Acquired with a Remidio Fundus on Phone (FOP) camera. 1659 by 2212 pixels: 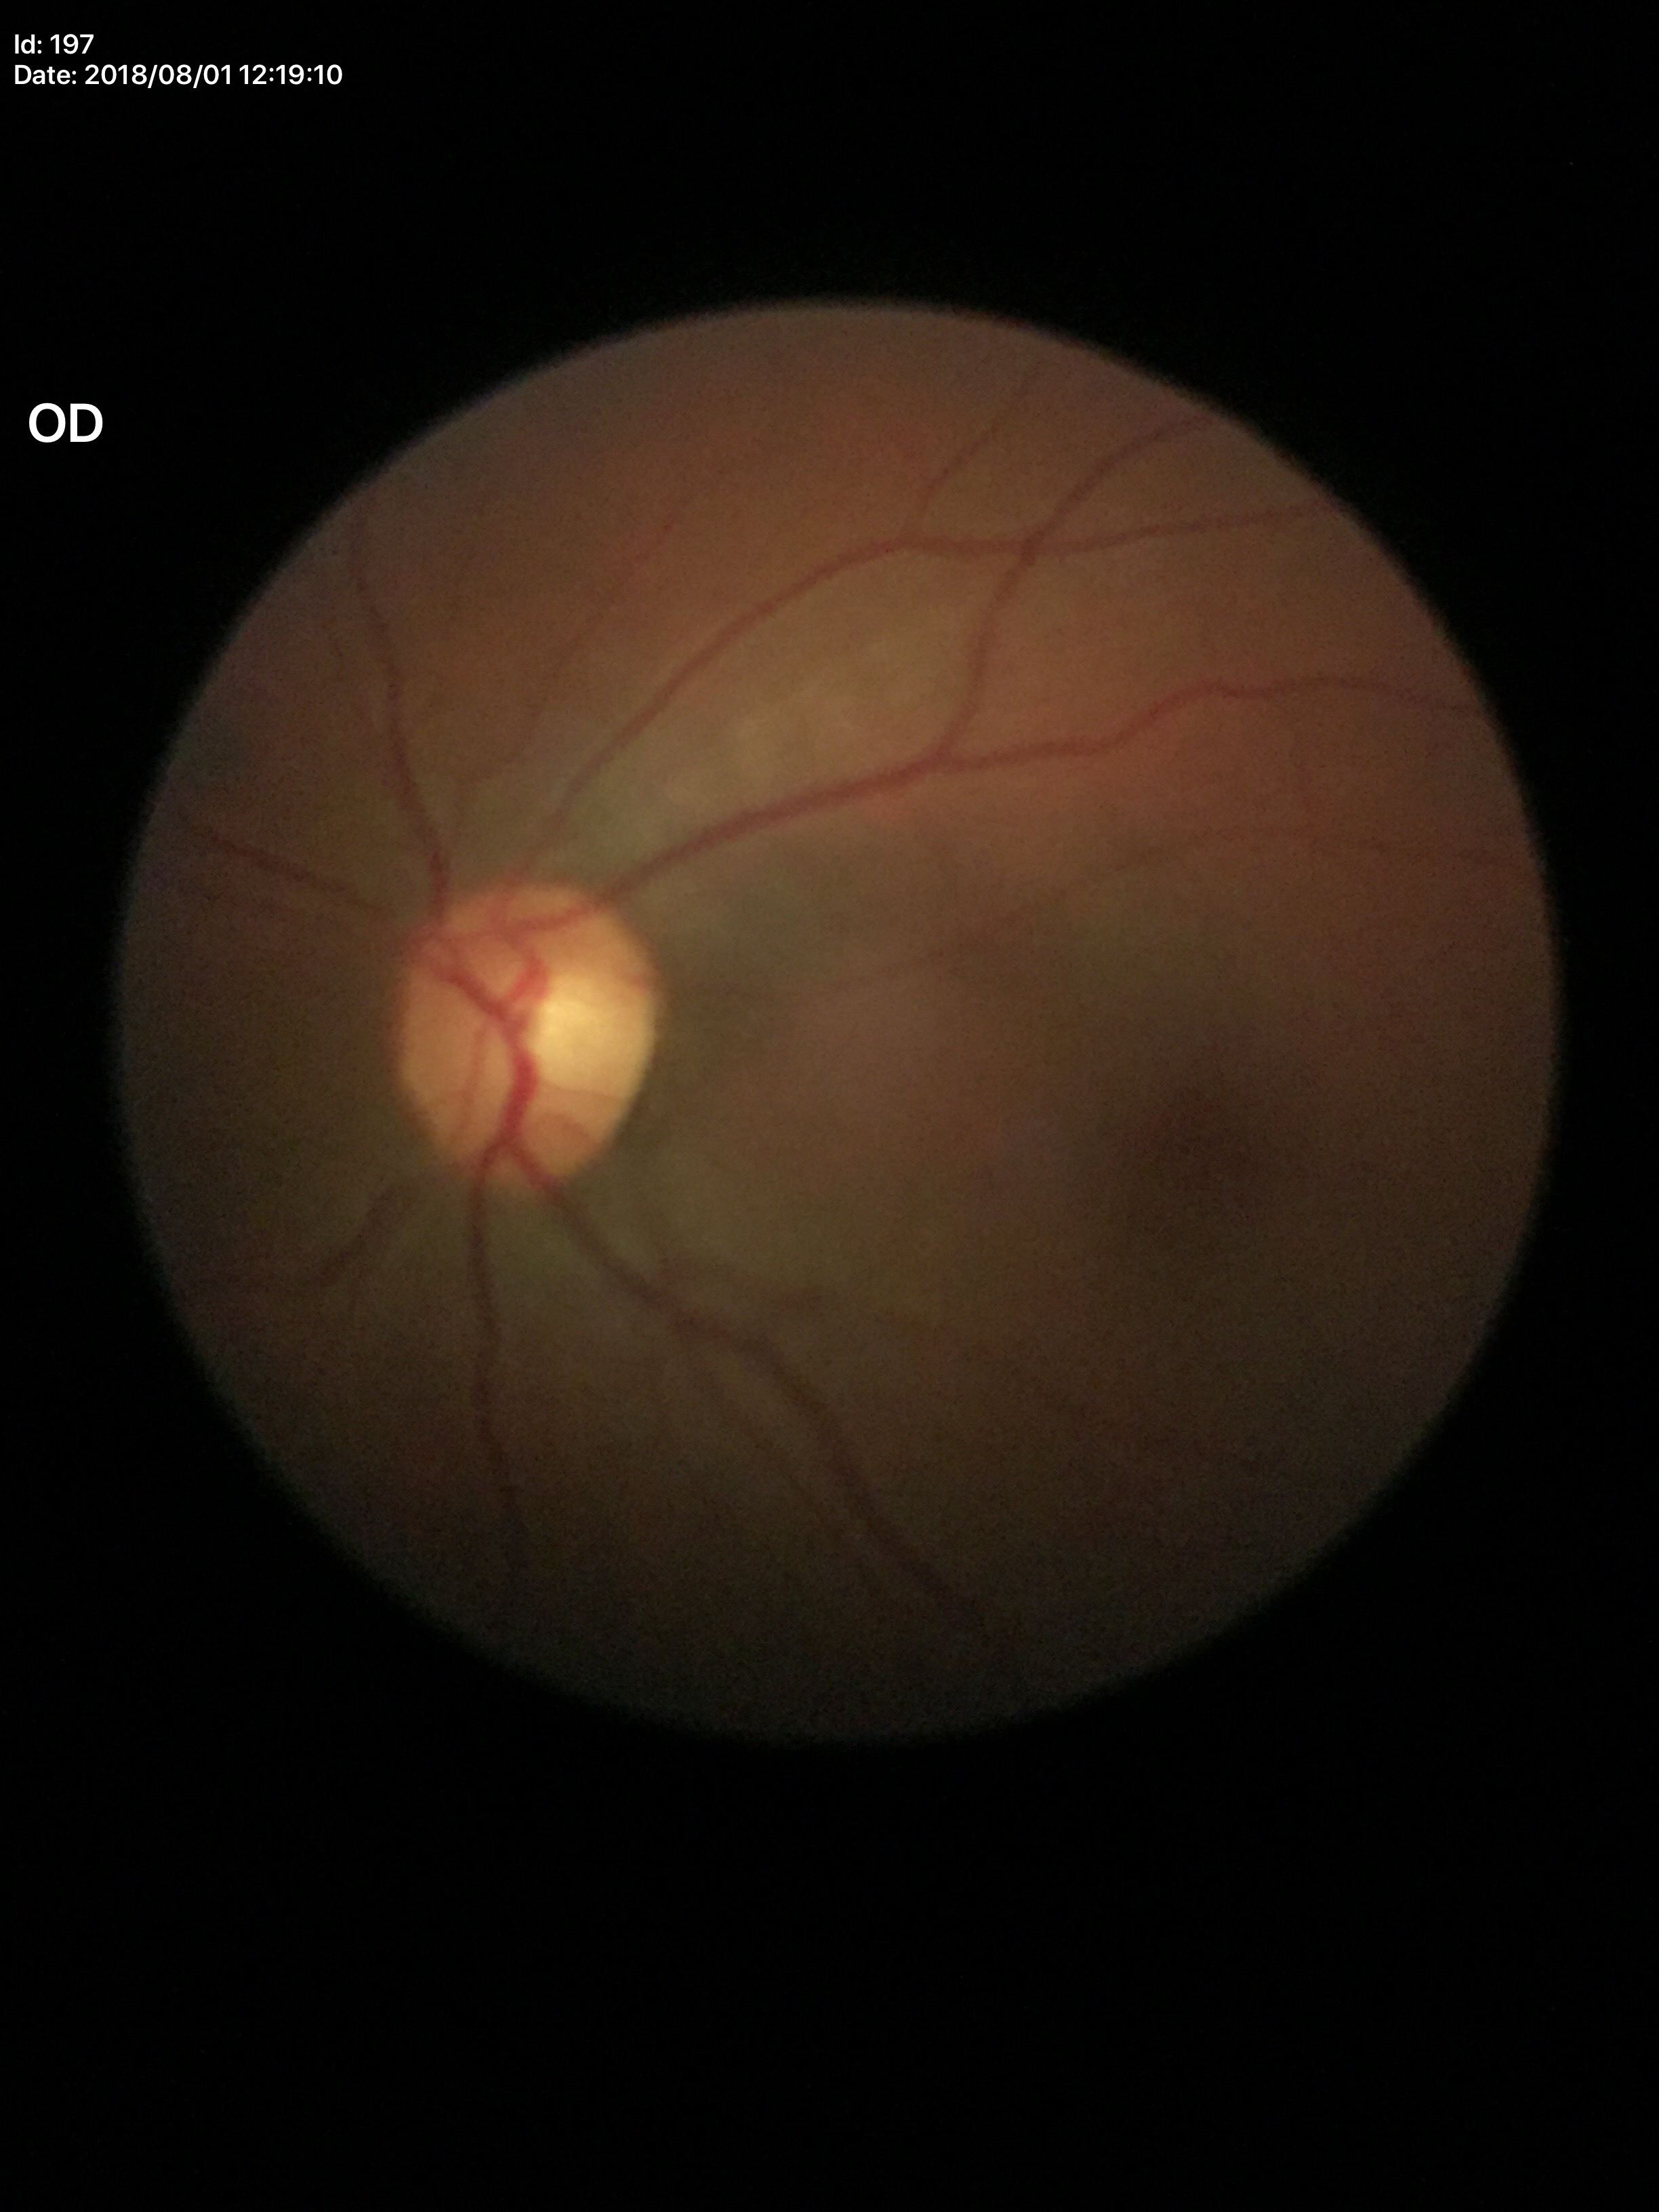 Glaucoma impression: negative (1 of 5 graders flagged glaucoma suspect). Vertical C/D ratio (VCDR) is 0.52.